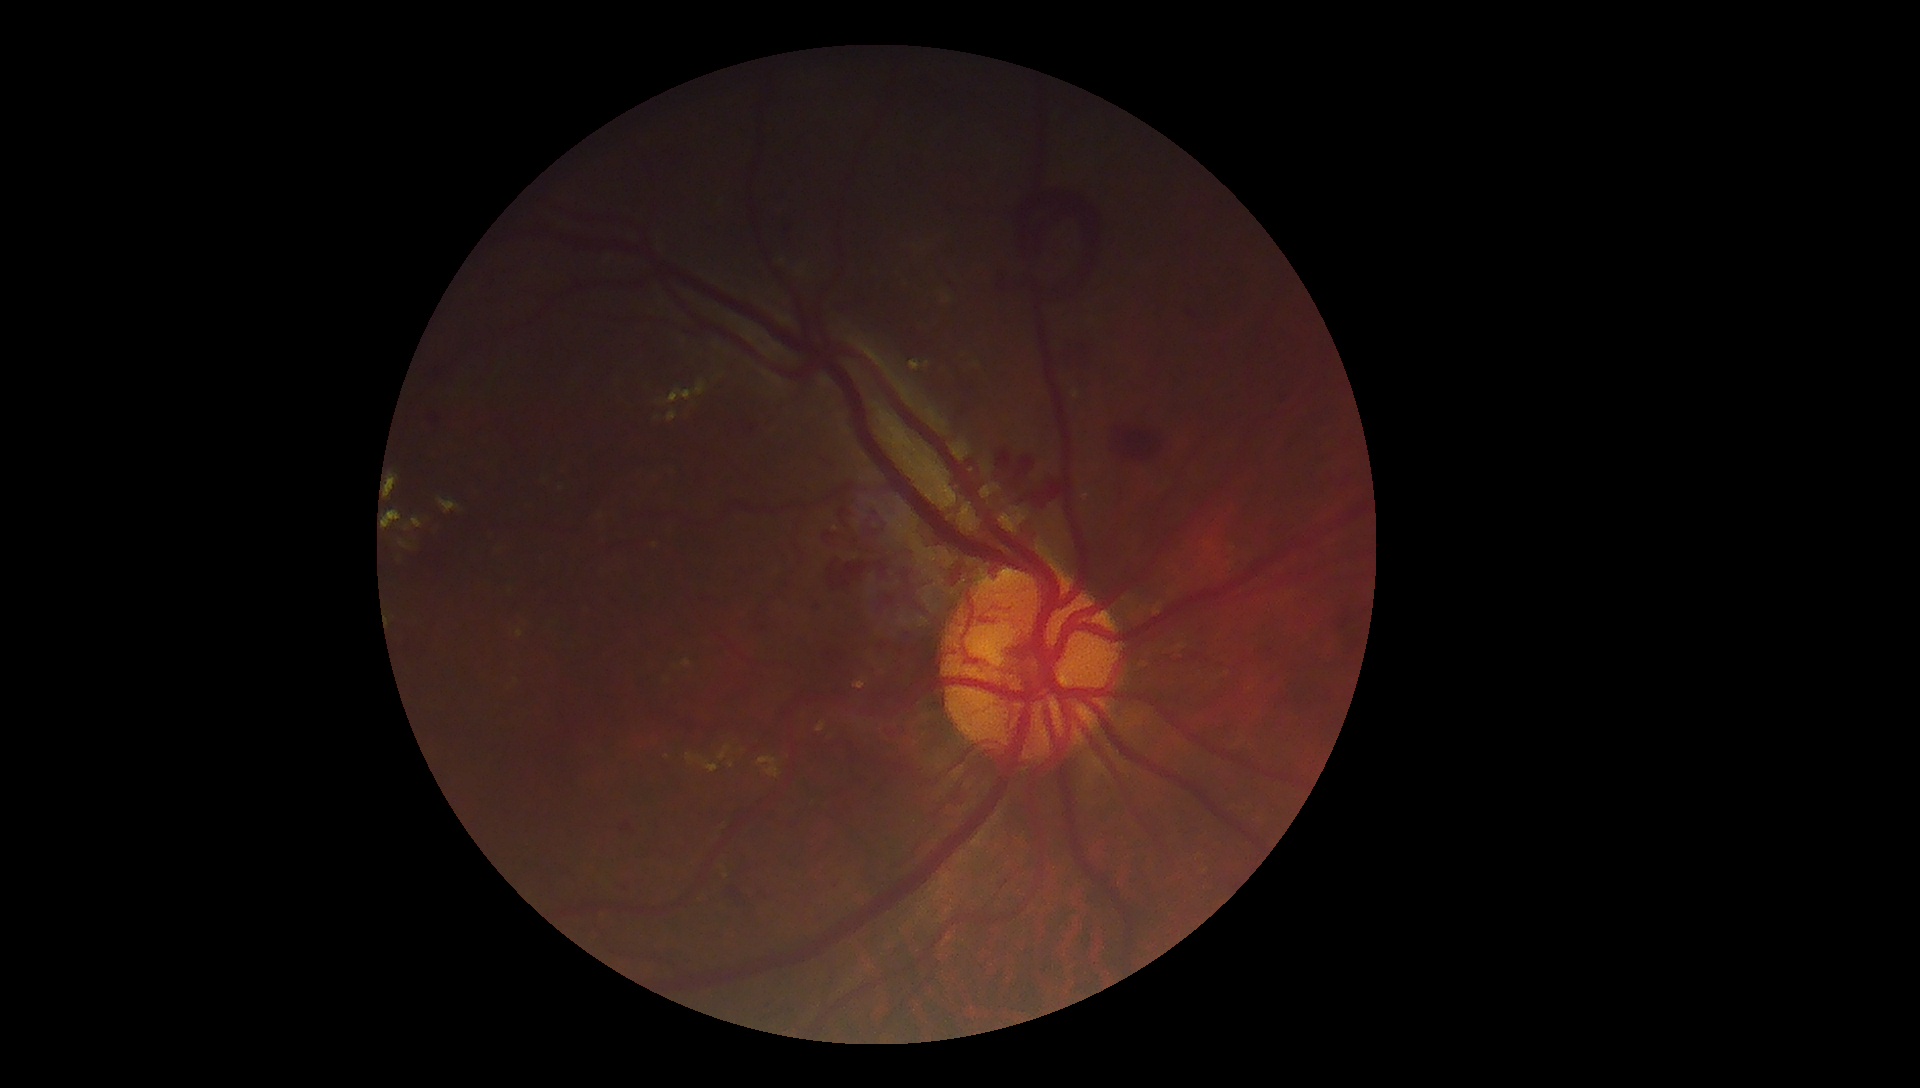 DR stage = proliferative diabetic retinopathy (grade 4).